Optic disc region of a color fundus photo:
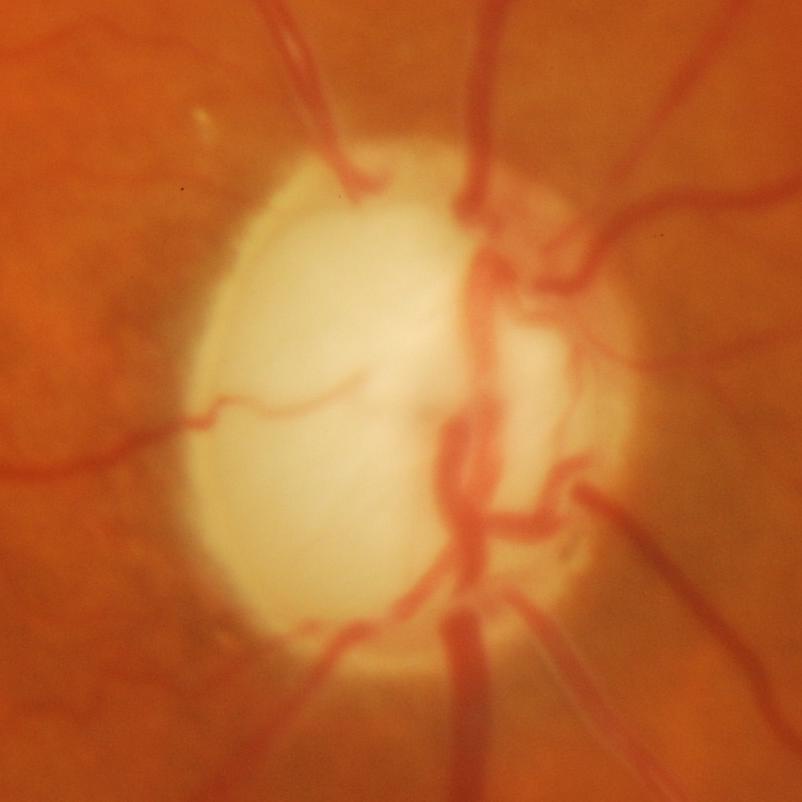 Showing glaucomatous findings.